848x848; camera: NIDEK AFC-230; posterior pole color fundus photograph
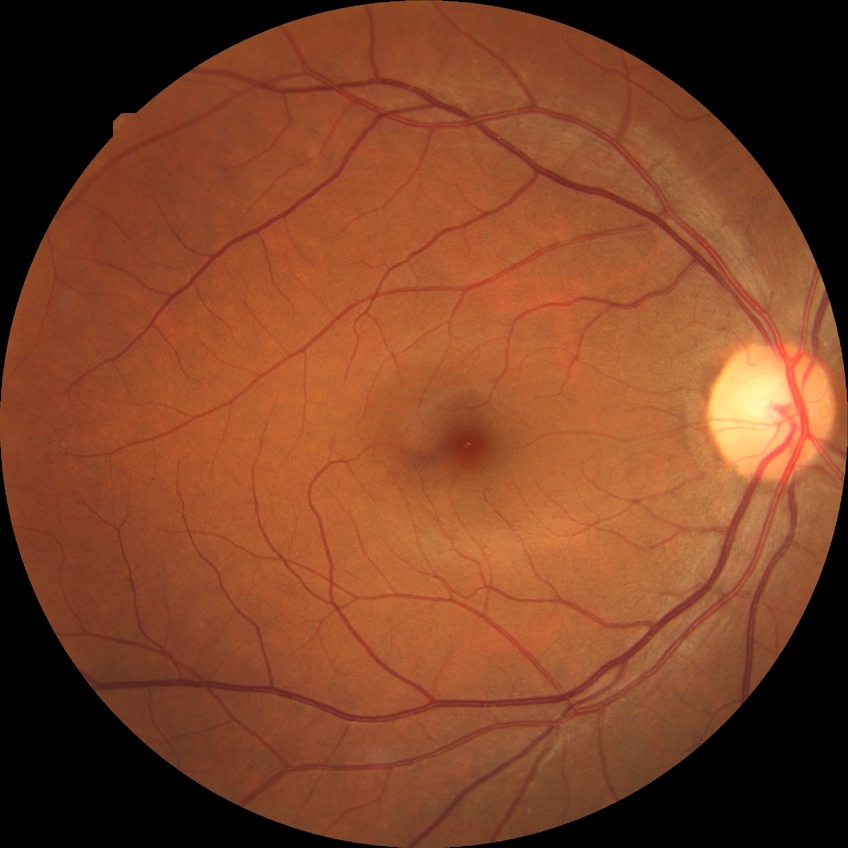

Assessment:
• diabetic retinopathy (DR): no diabetic retinopathy (NDR)